Wide-field fundus photograph from neonatal ROP screening: 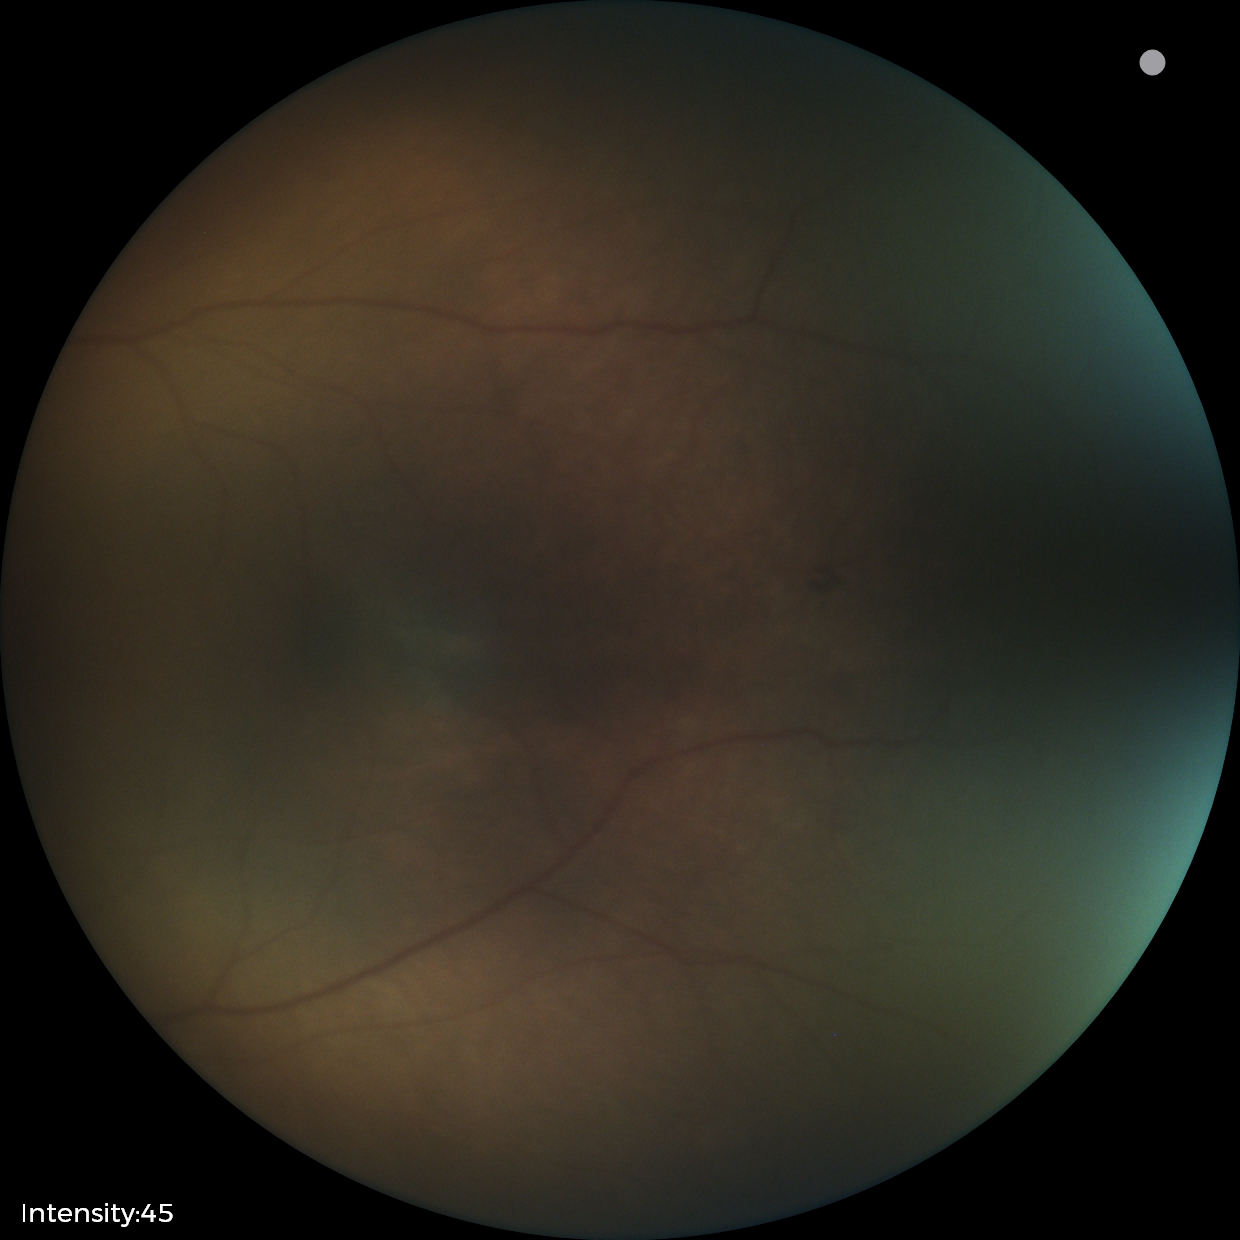

Screening examination consistent with status post retinopathy of prematurity (ROP).
Plus disease absent.